Diabetic retinopathy graded by the modified Davis classification
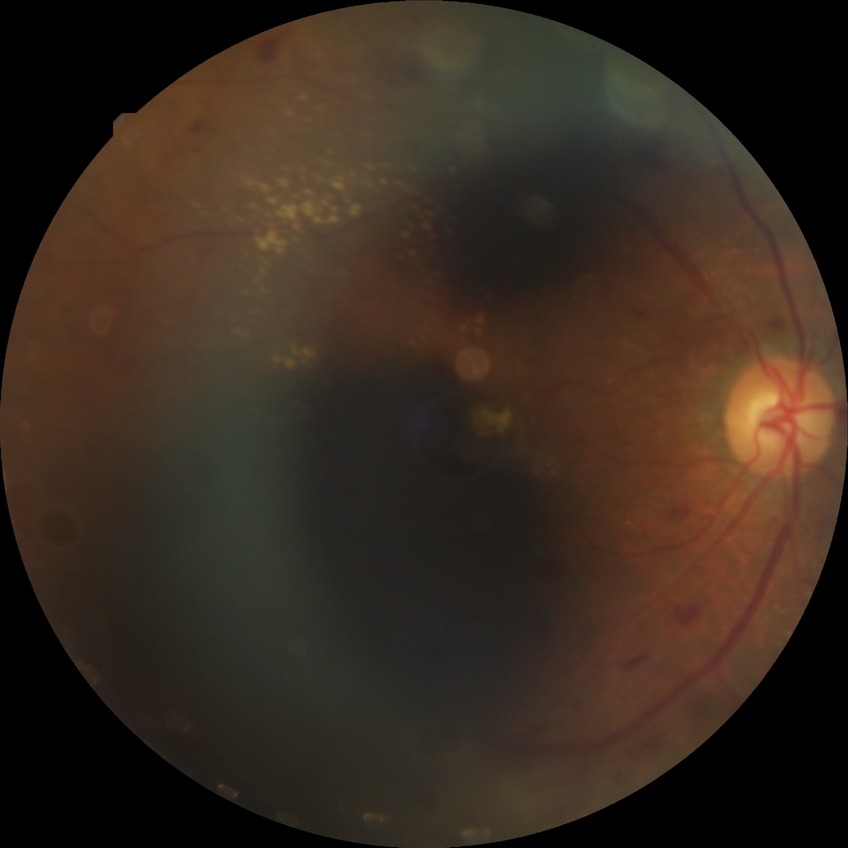

Diabetic retinopathy (DR) is PPDR (pre-proliferative diabetic retinopathy).